1240 by 1240 pixels; infant wide-field fundus photograph — 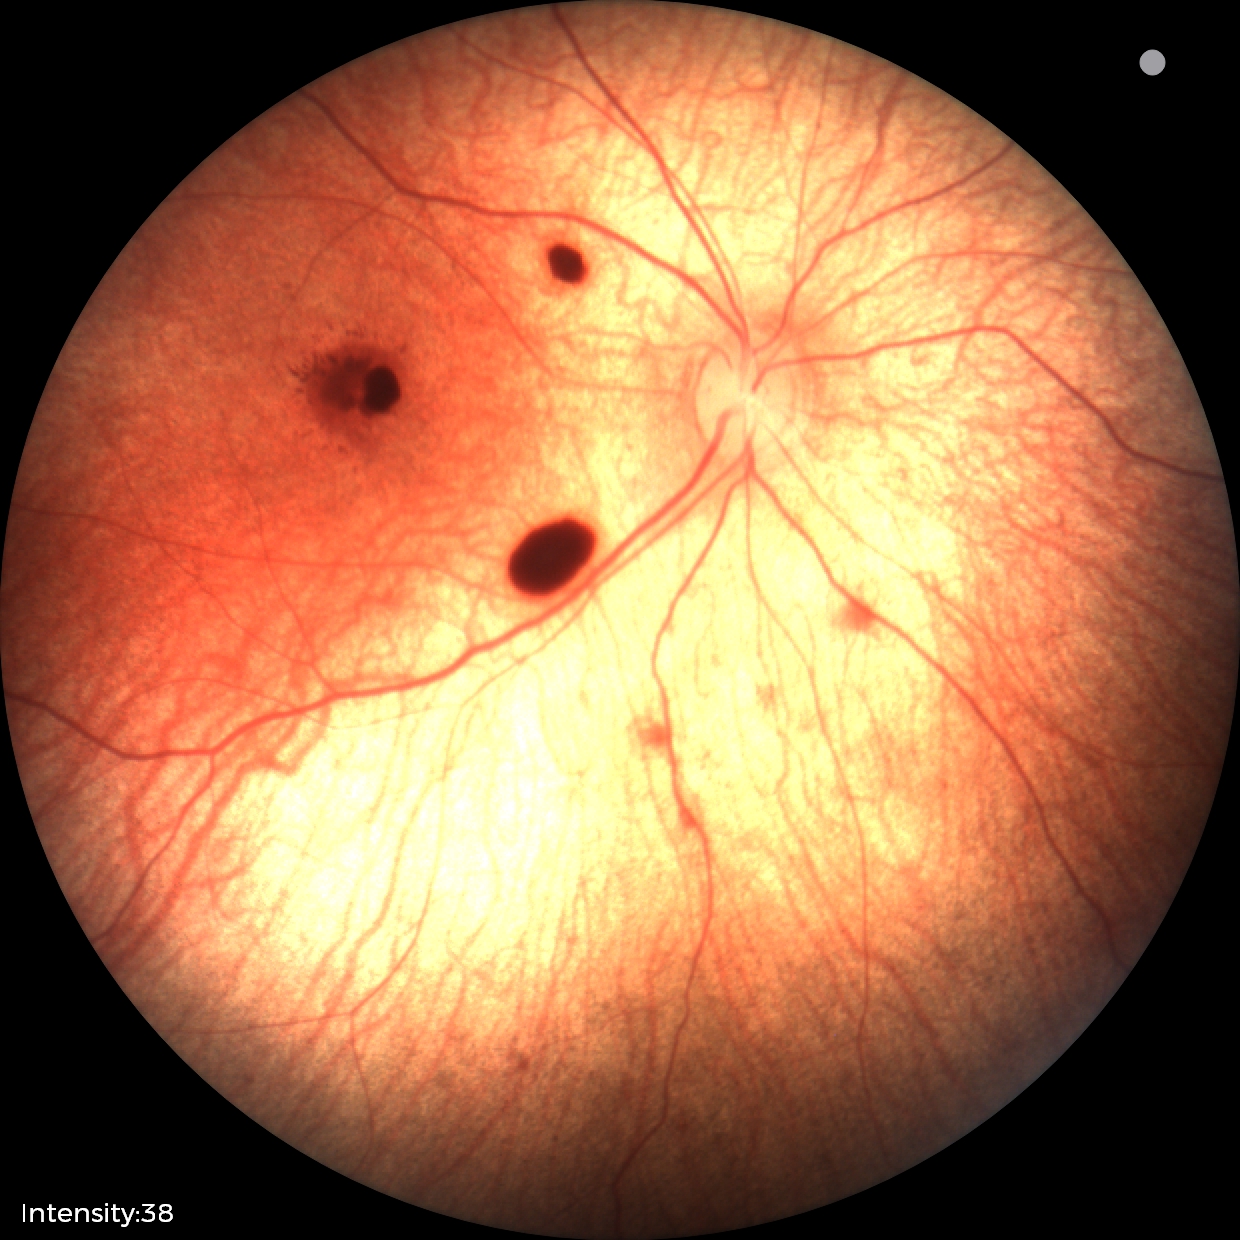
From an examination with diagnosis of retinal hemorrhages.